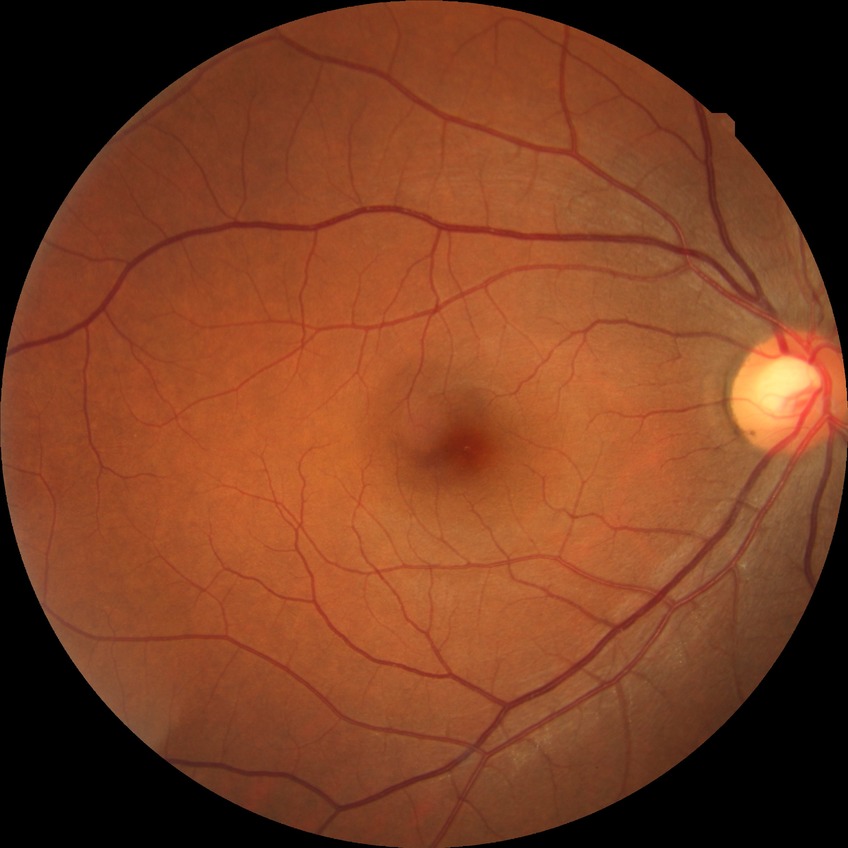 diabetic retinopathy (DR): no diabetic retinopathy (NDR).